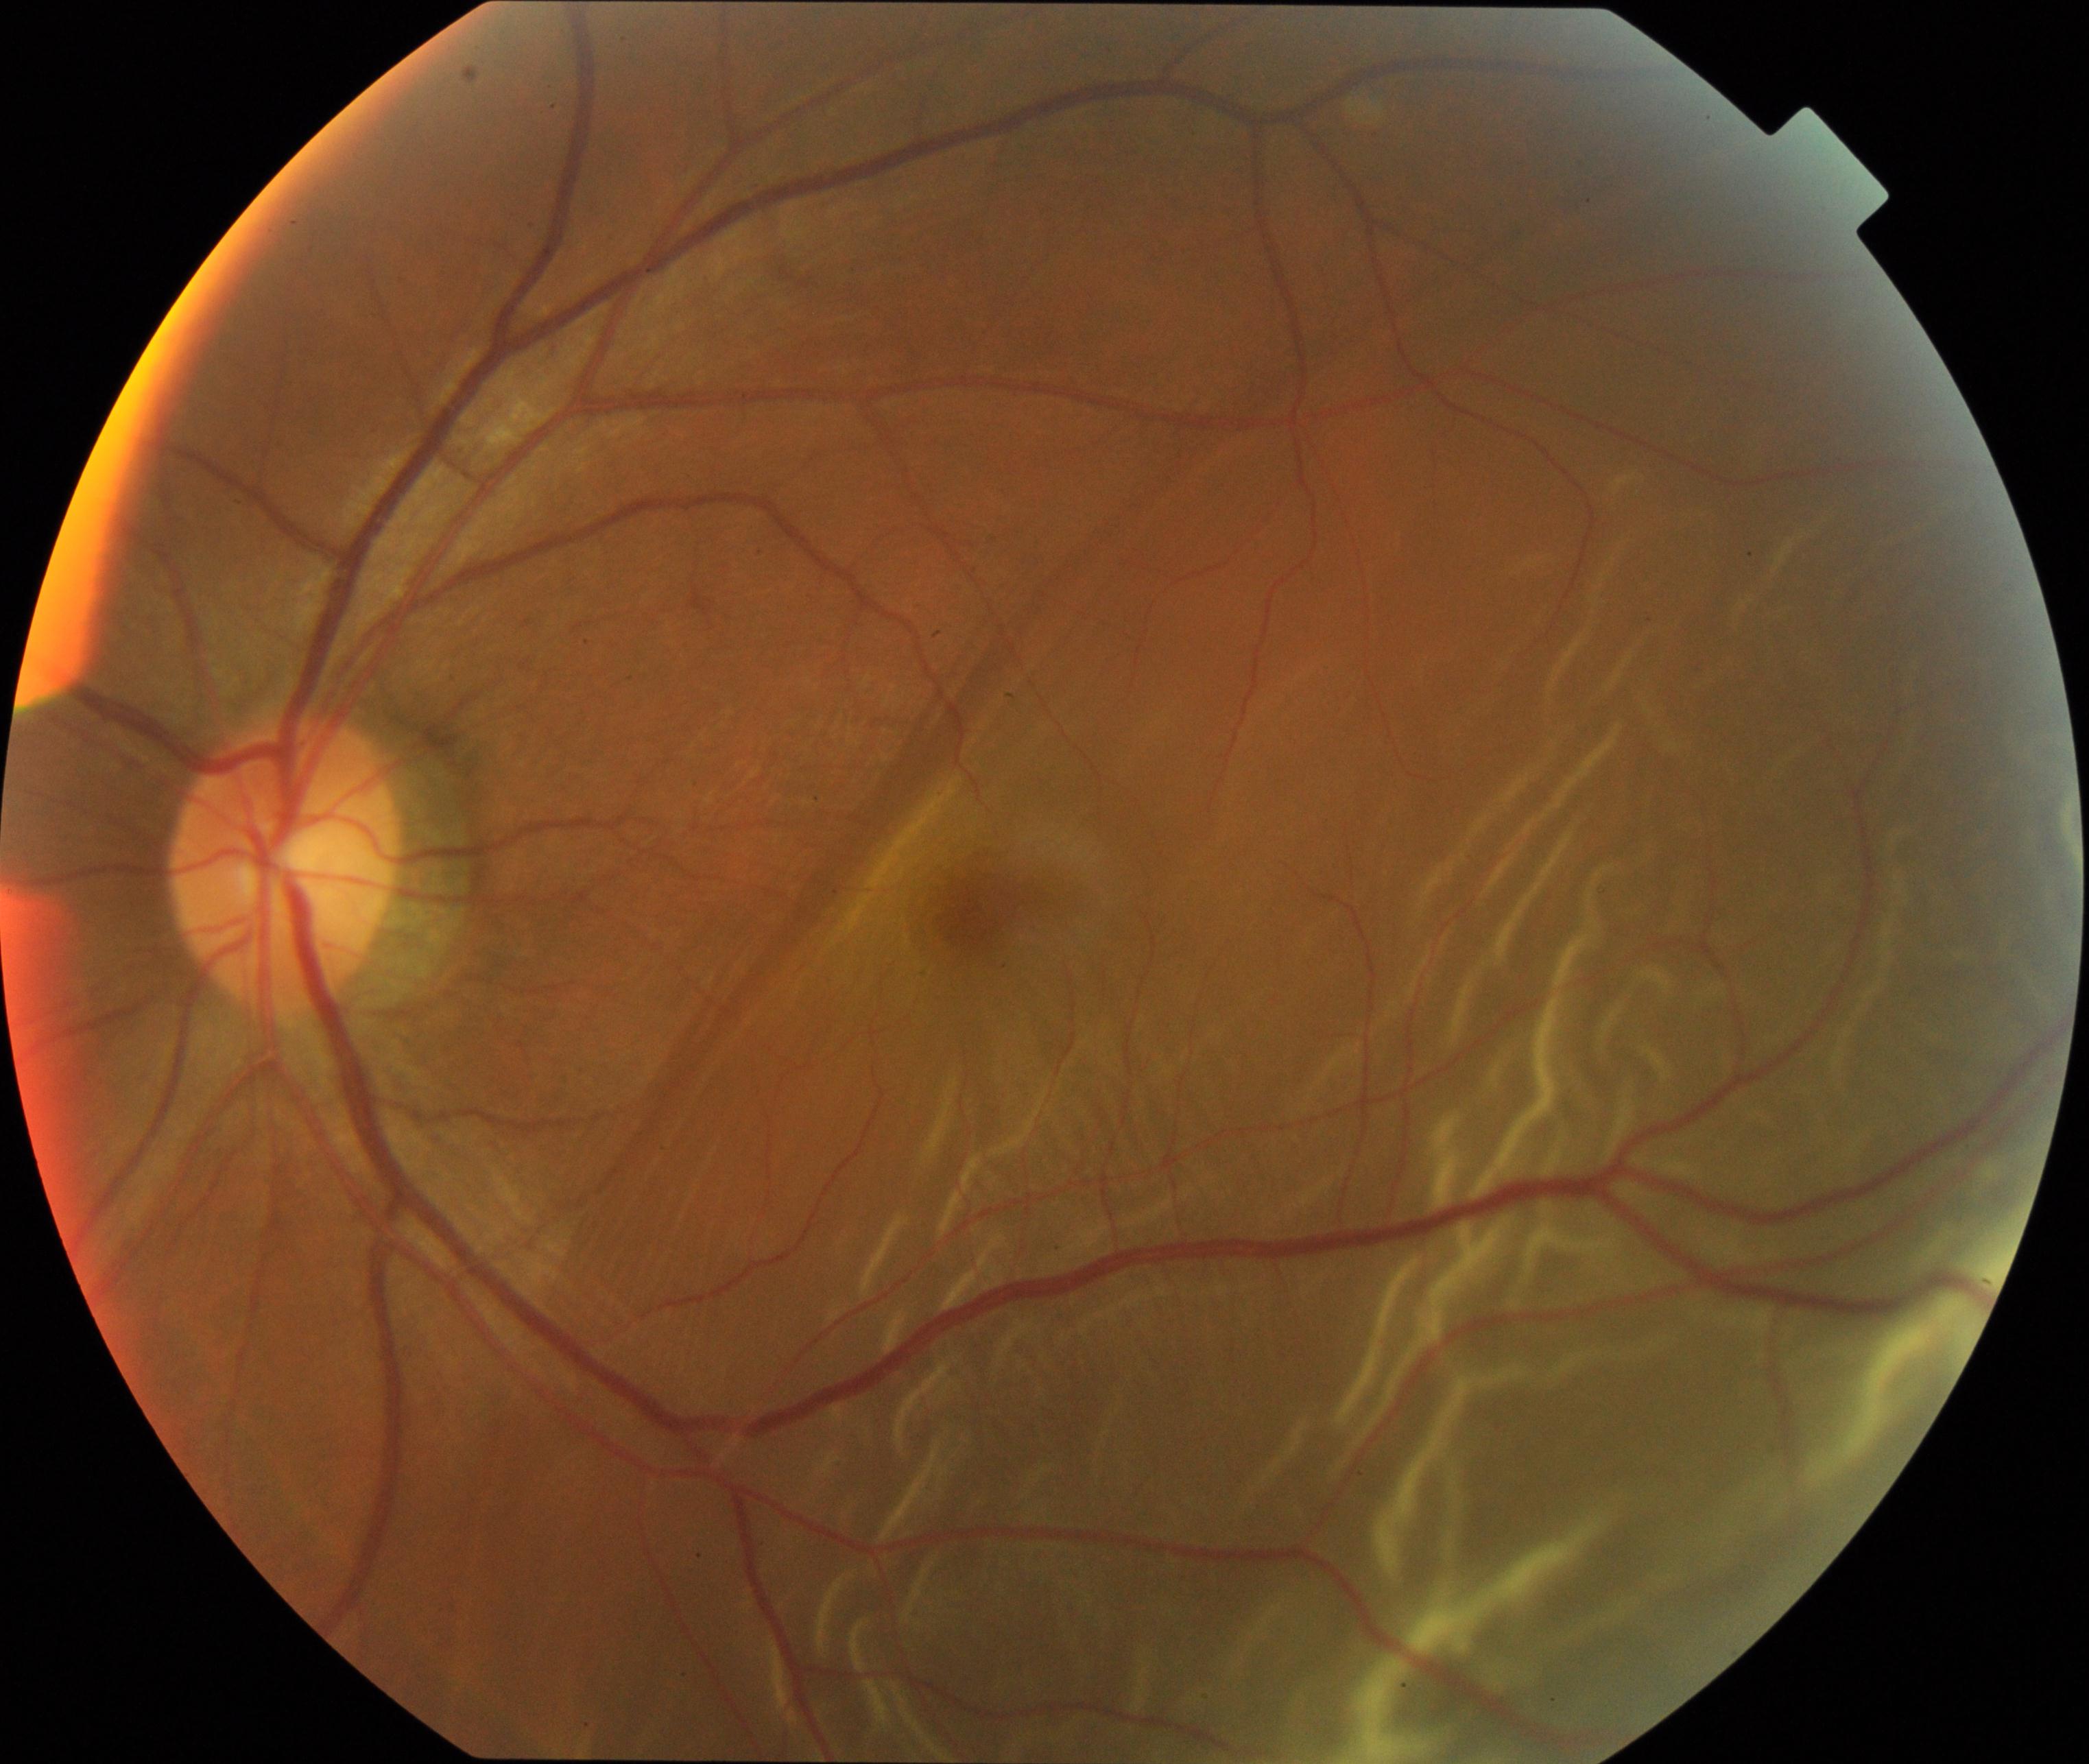

Primary finding: rhegmatogenous retinal detachment. Features include slightly opaque, convex or corrugated appearance of elevated retina, sometimes with retinal breaks in view.